Wide-field fundus photograph of an infant; image size 1440x1080:
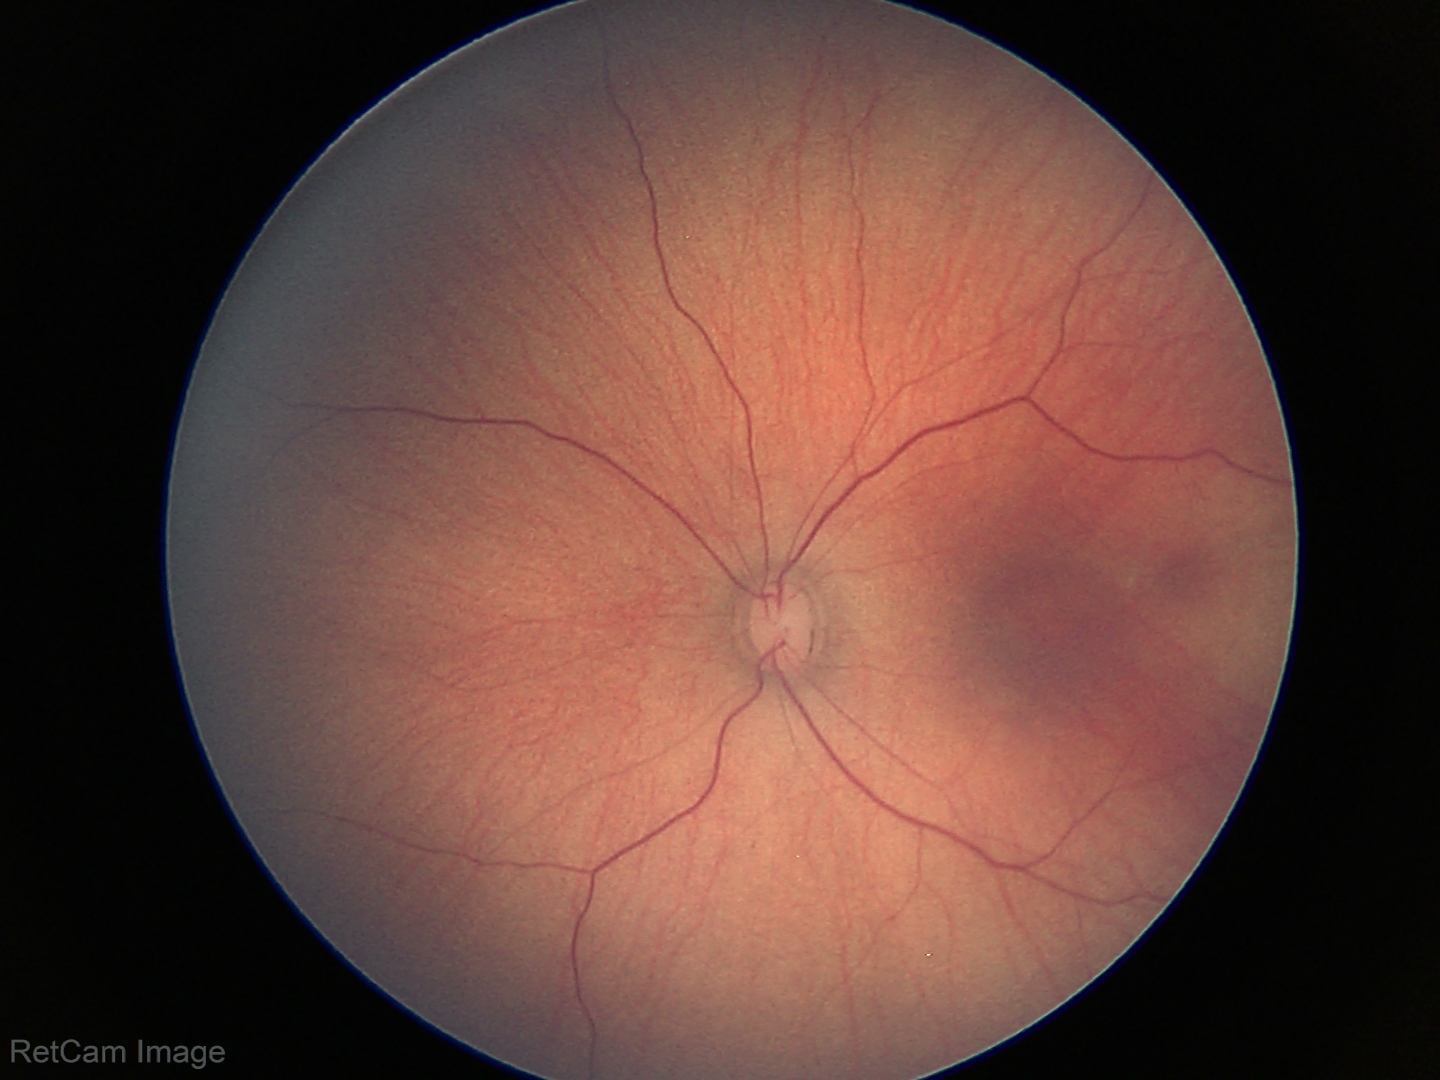
Examination with physiological retinal findings.